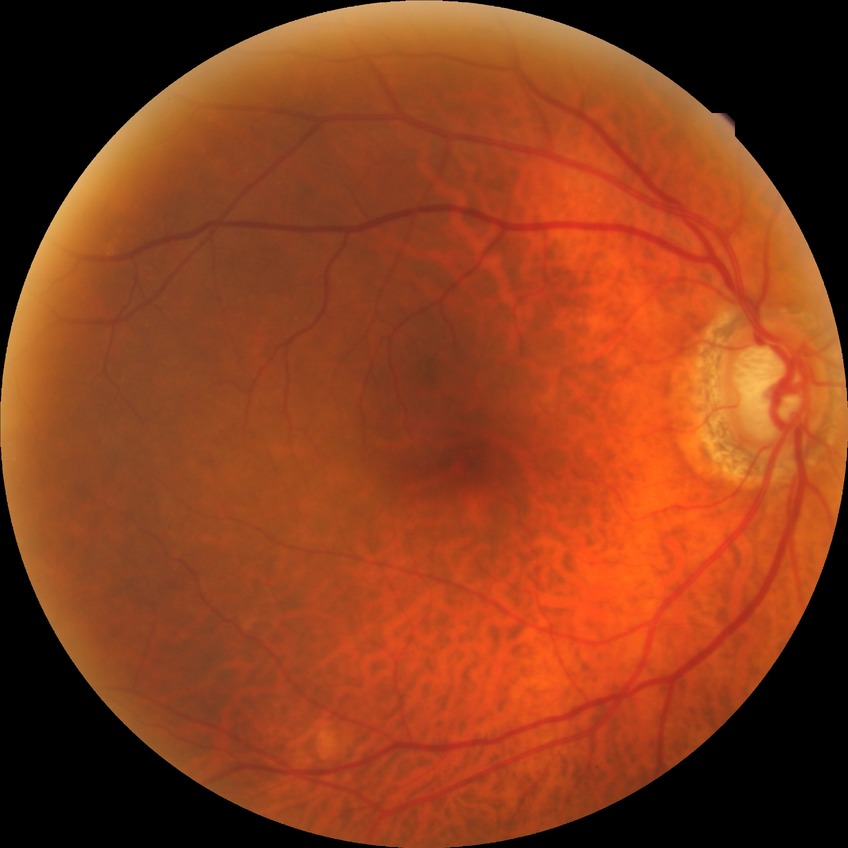 Diabetic retinopathy (DR) is NDR (no diabetic retinopathy).